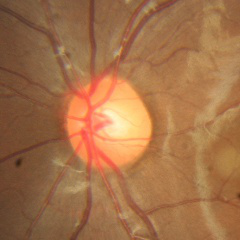 Q: What is the glaucoma diagnosis?
A: No glaucoma.